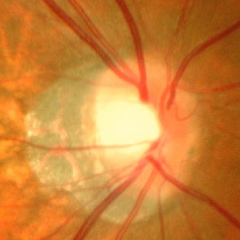
Glaucomatous optic neuropathy is present. Findings consistent with advanced glaucomatous optic neuropathy.